100° field of view (Phoenix ICON) · wide-field fundus photograph of an infant · 1240 x 1240 pixels — 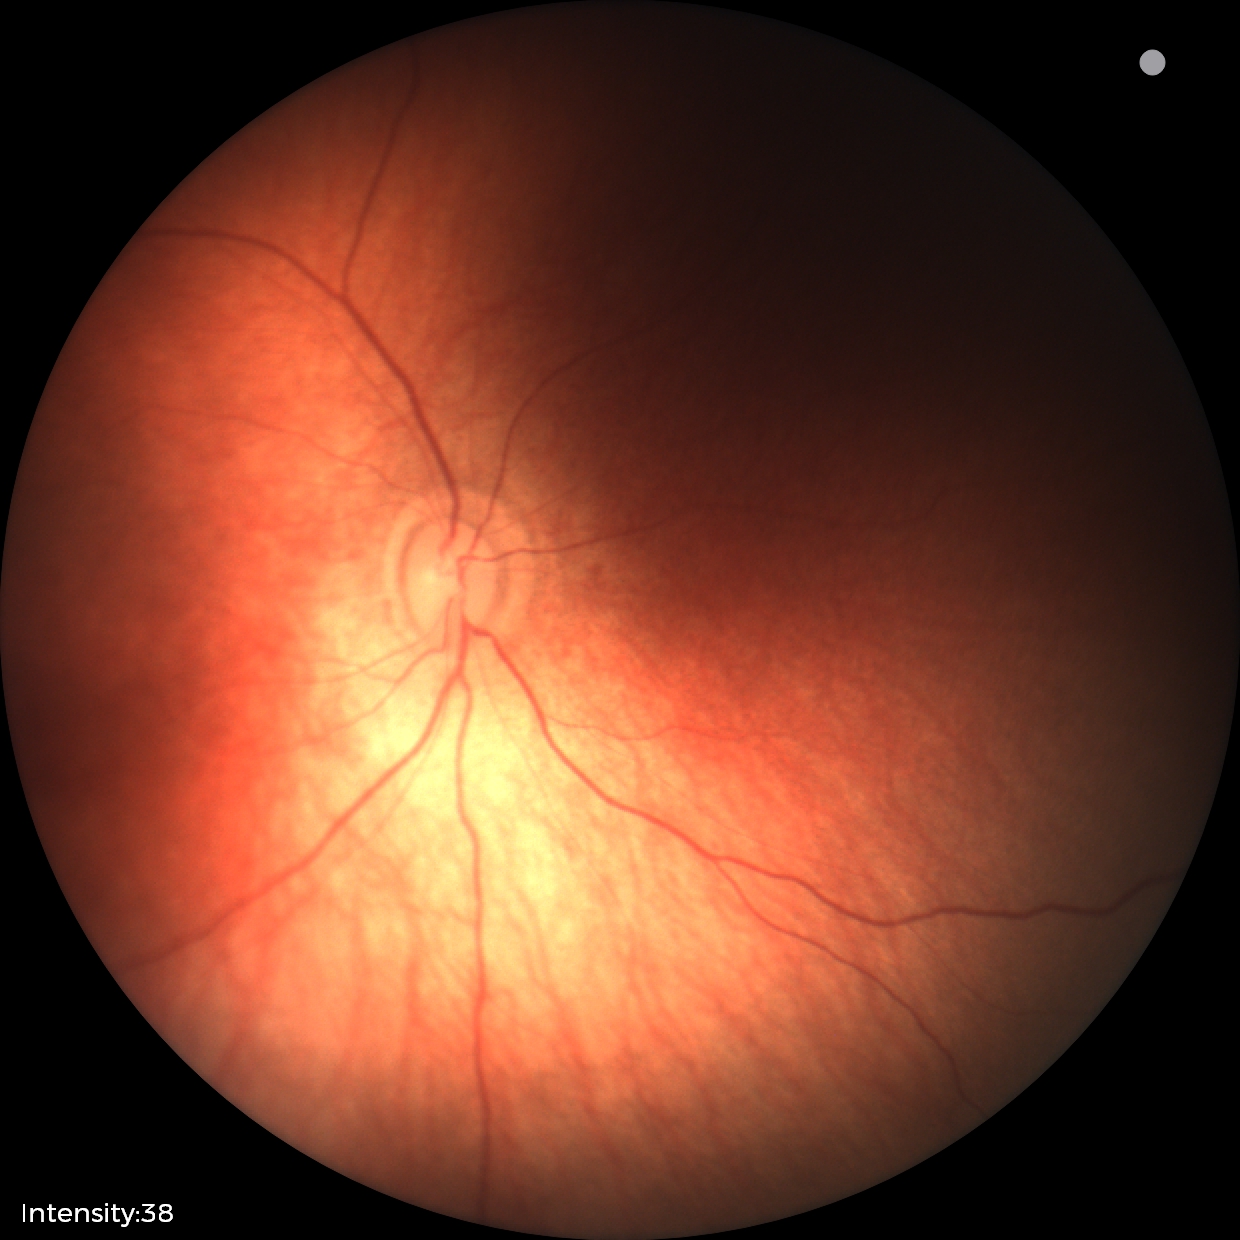
Diagnosis: physiological.